Camera: Phoenix ICON (100° FOV) · pediatric wide-field fundus photograph · image size 1240x1240: 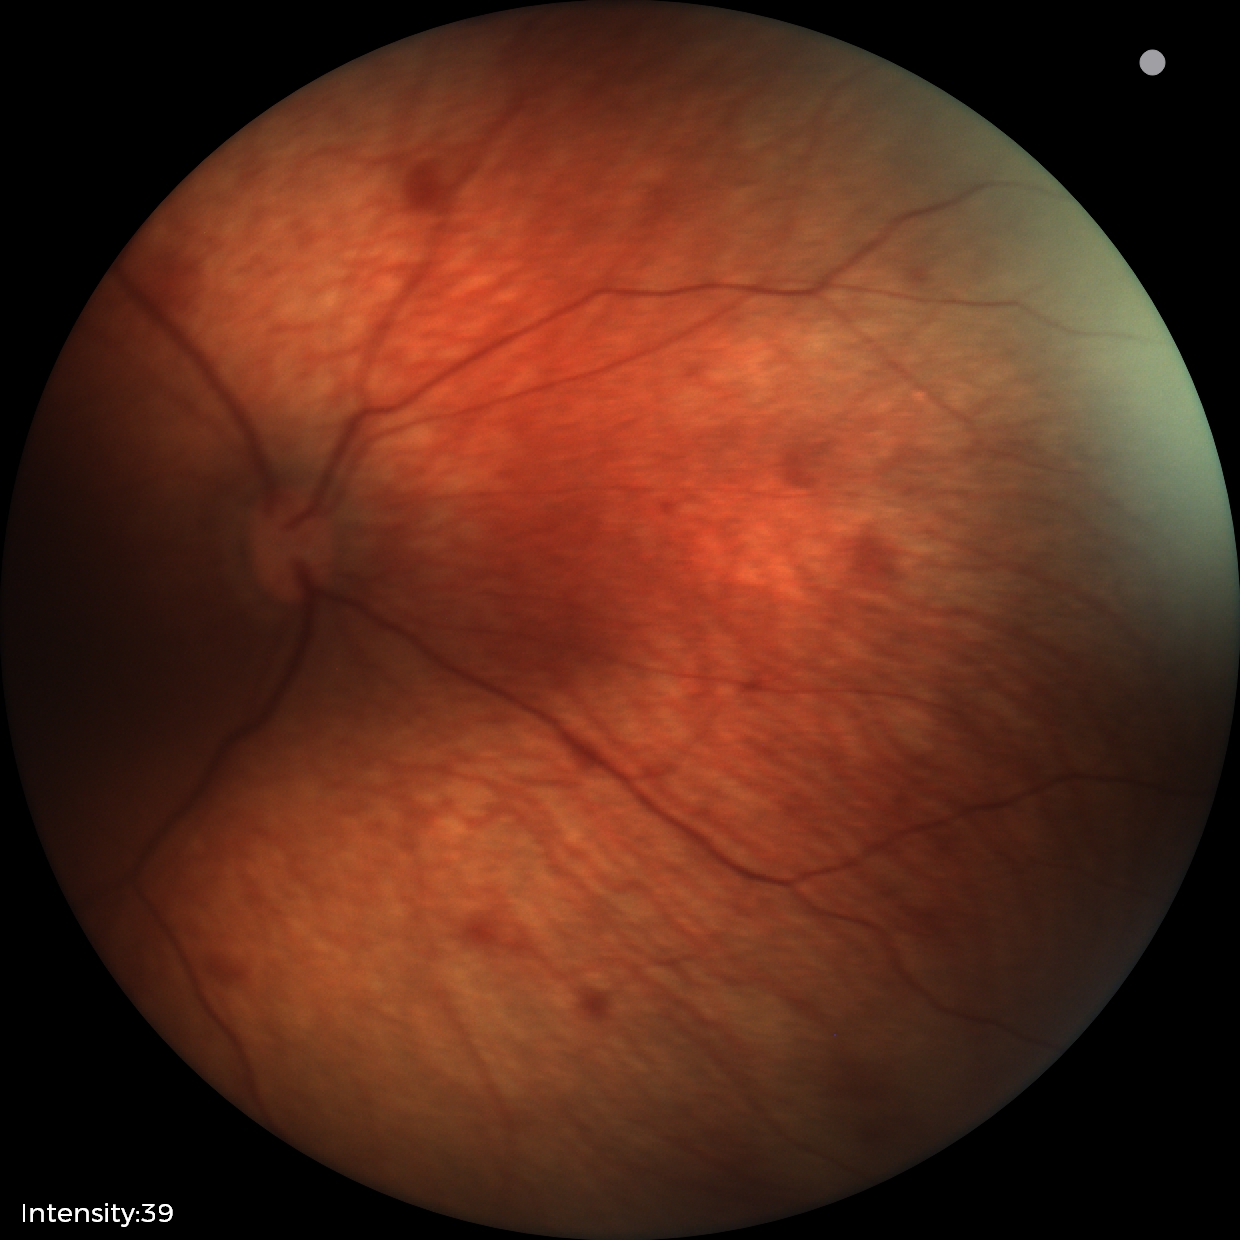 Screening examination consistent with retinal hemorrhages.